Wide-field fundus photograph of an infant.
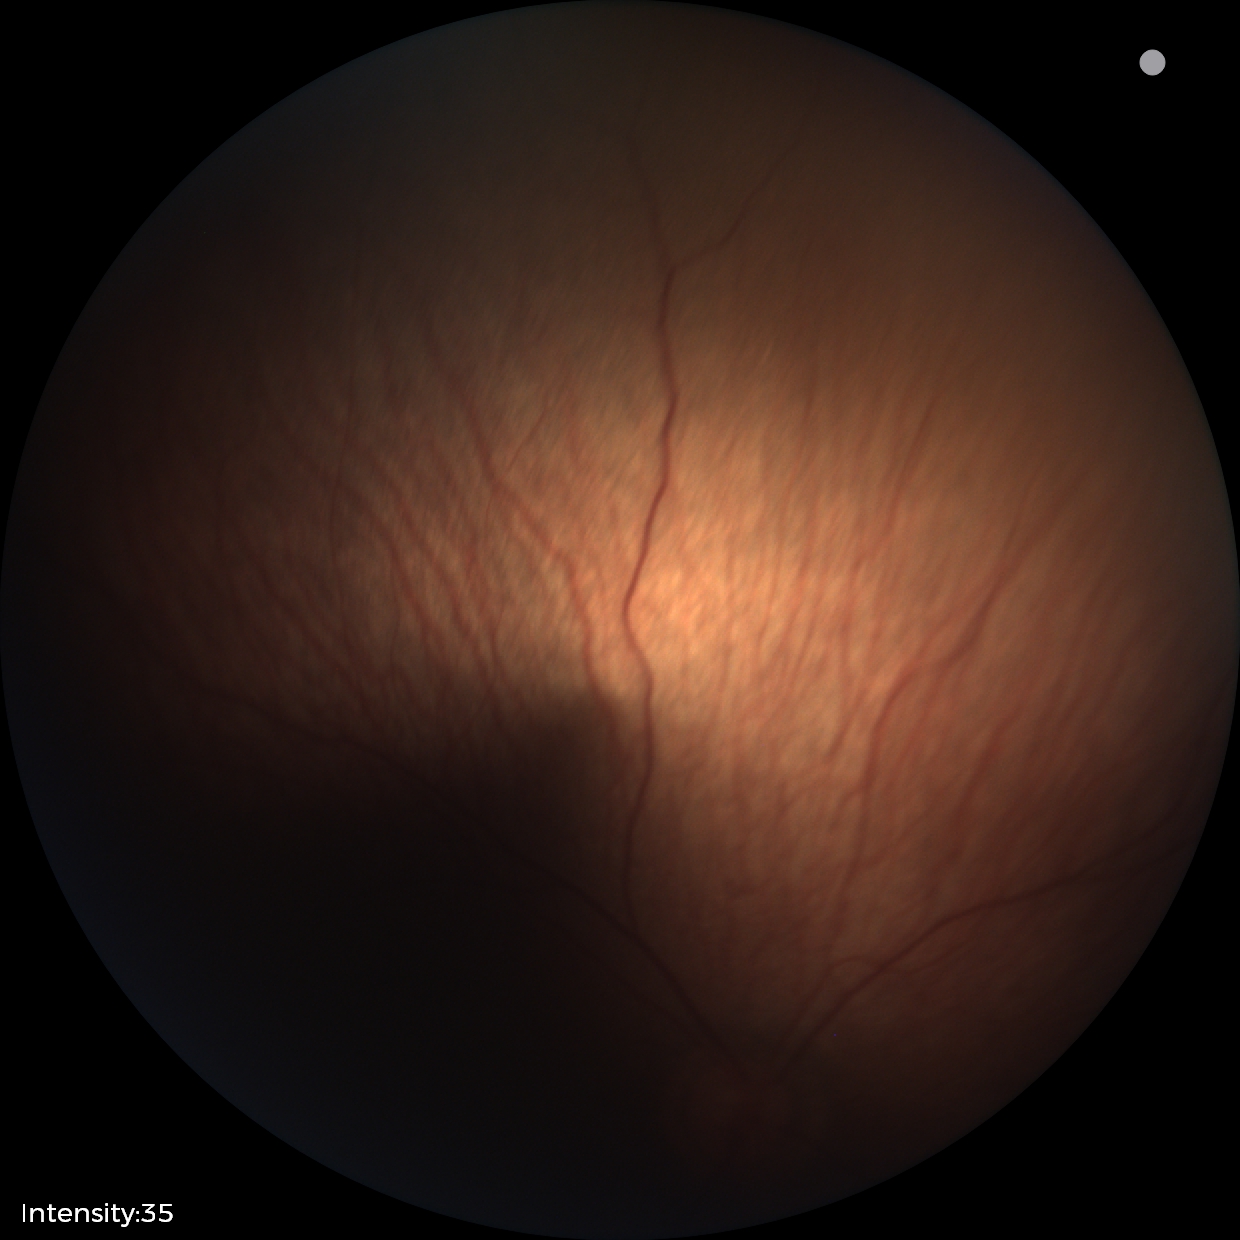

Impression: no abnormalities.